Wide-field fundus image from infant ROP screening. 1240x1240:
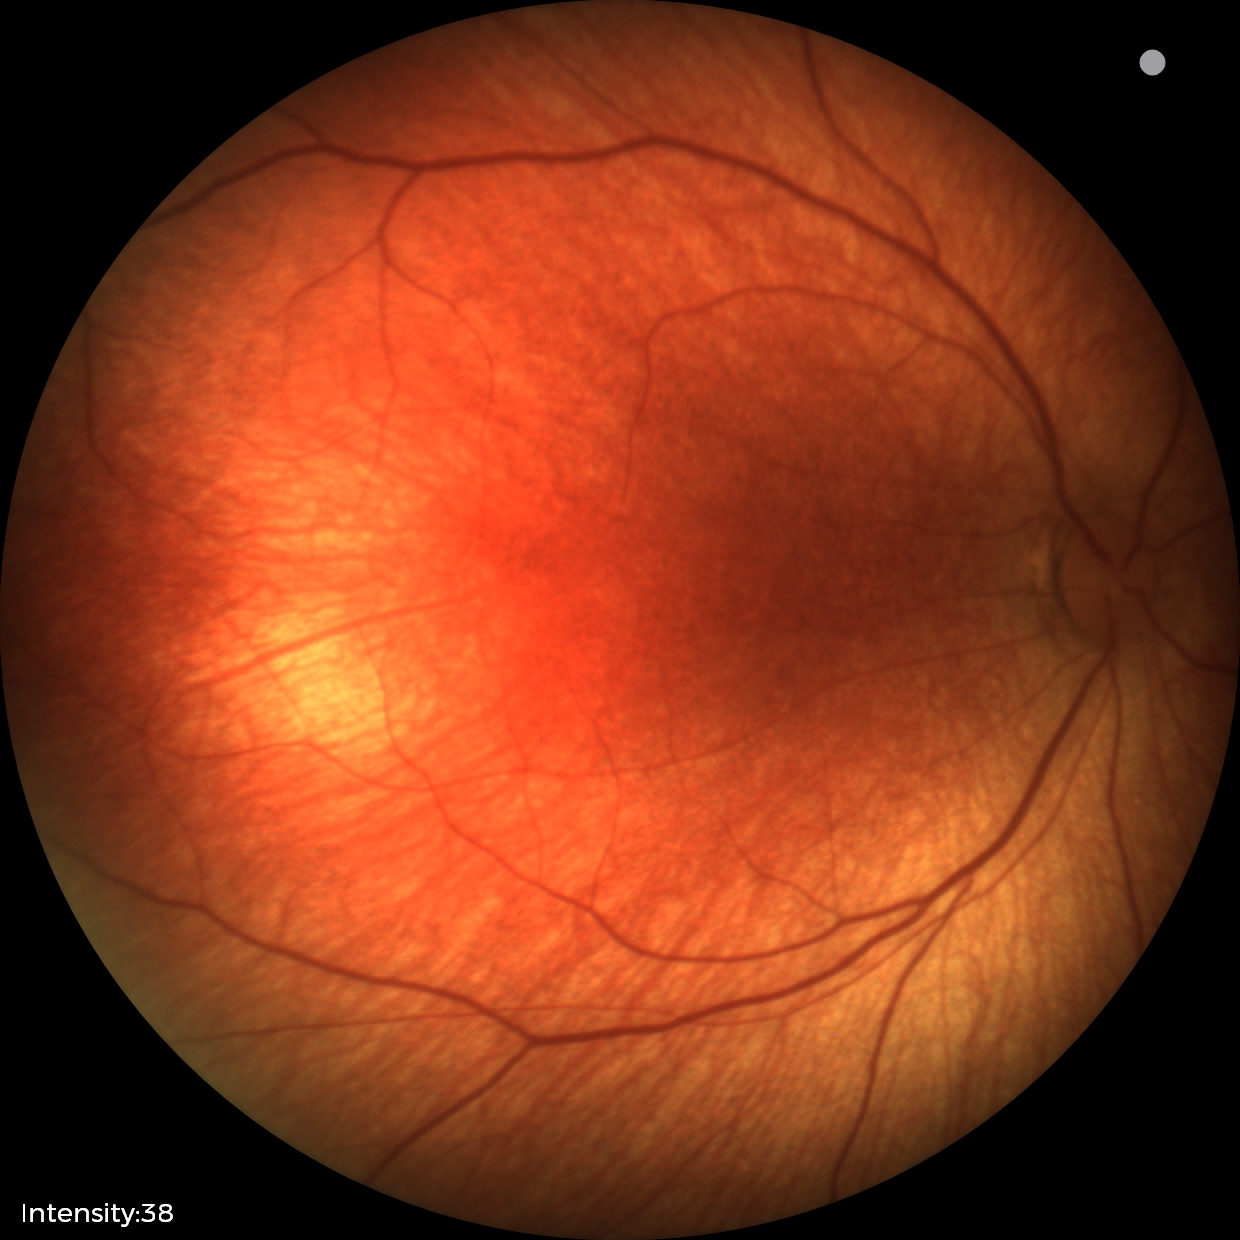
Impression = no abnormalities